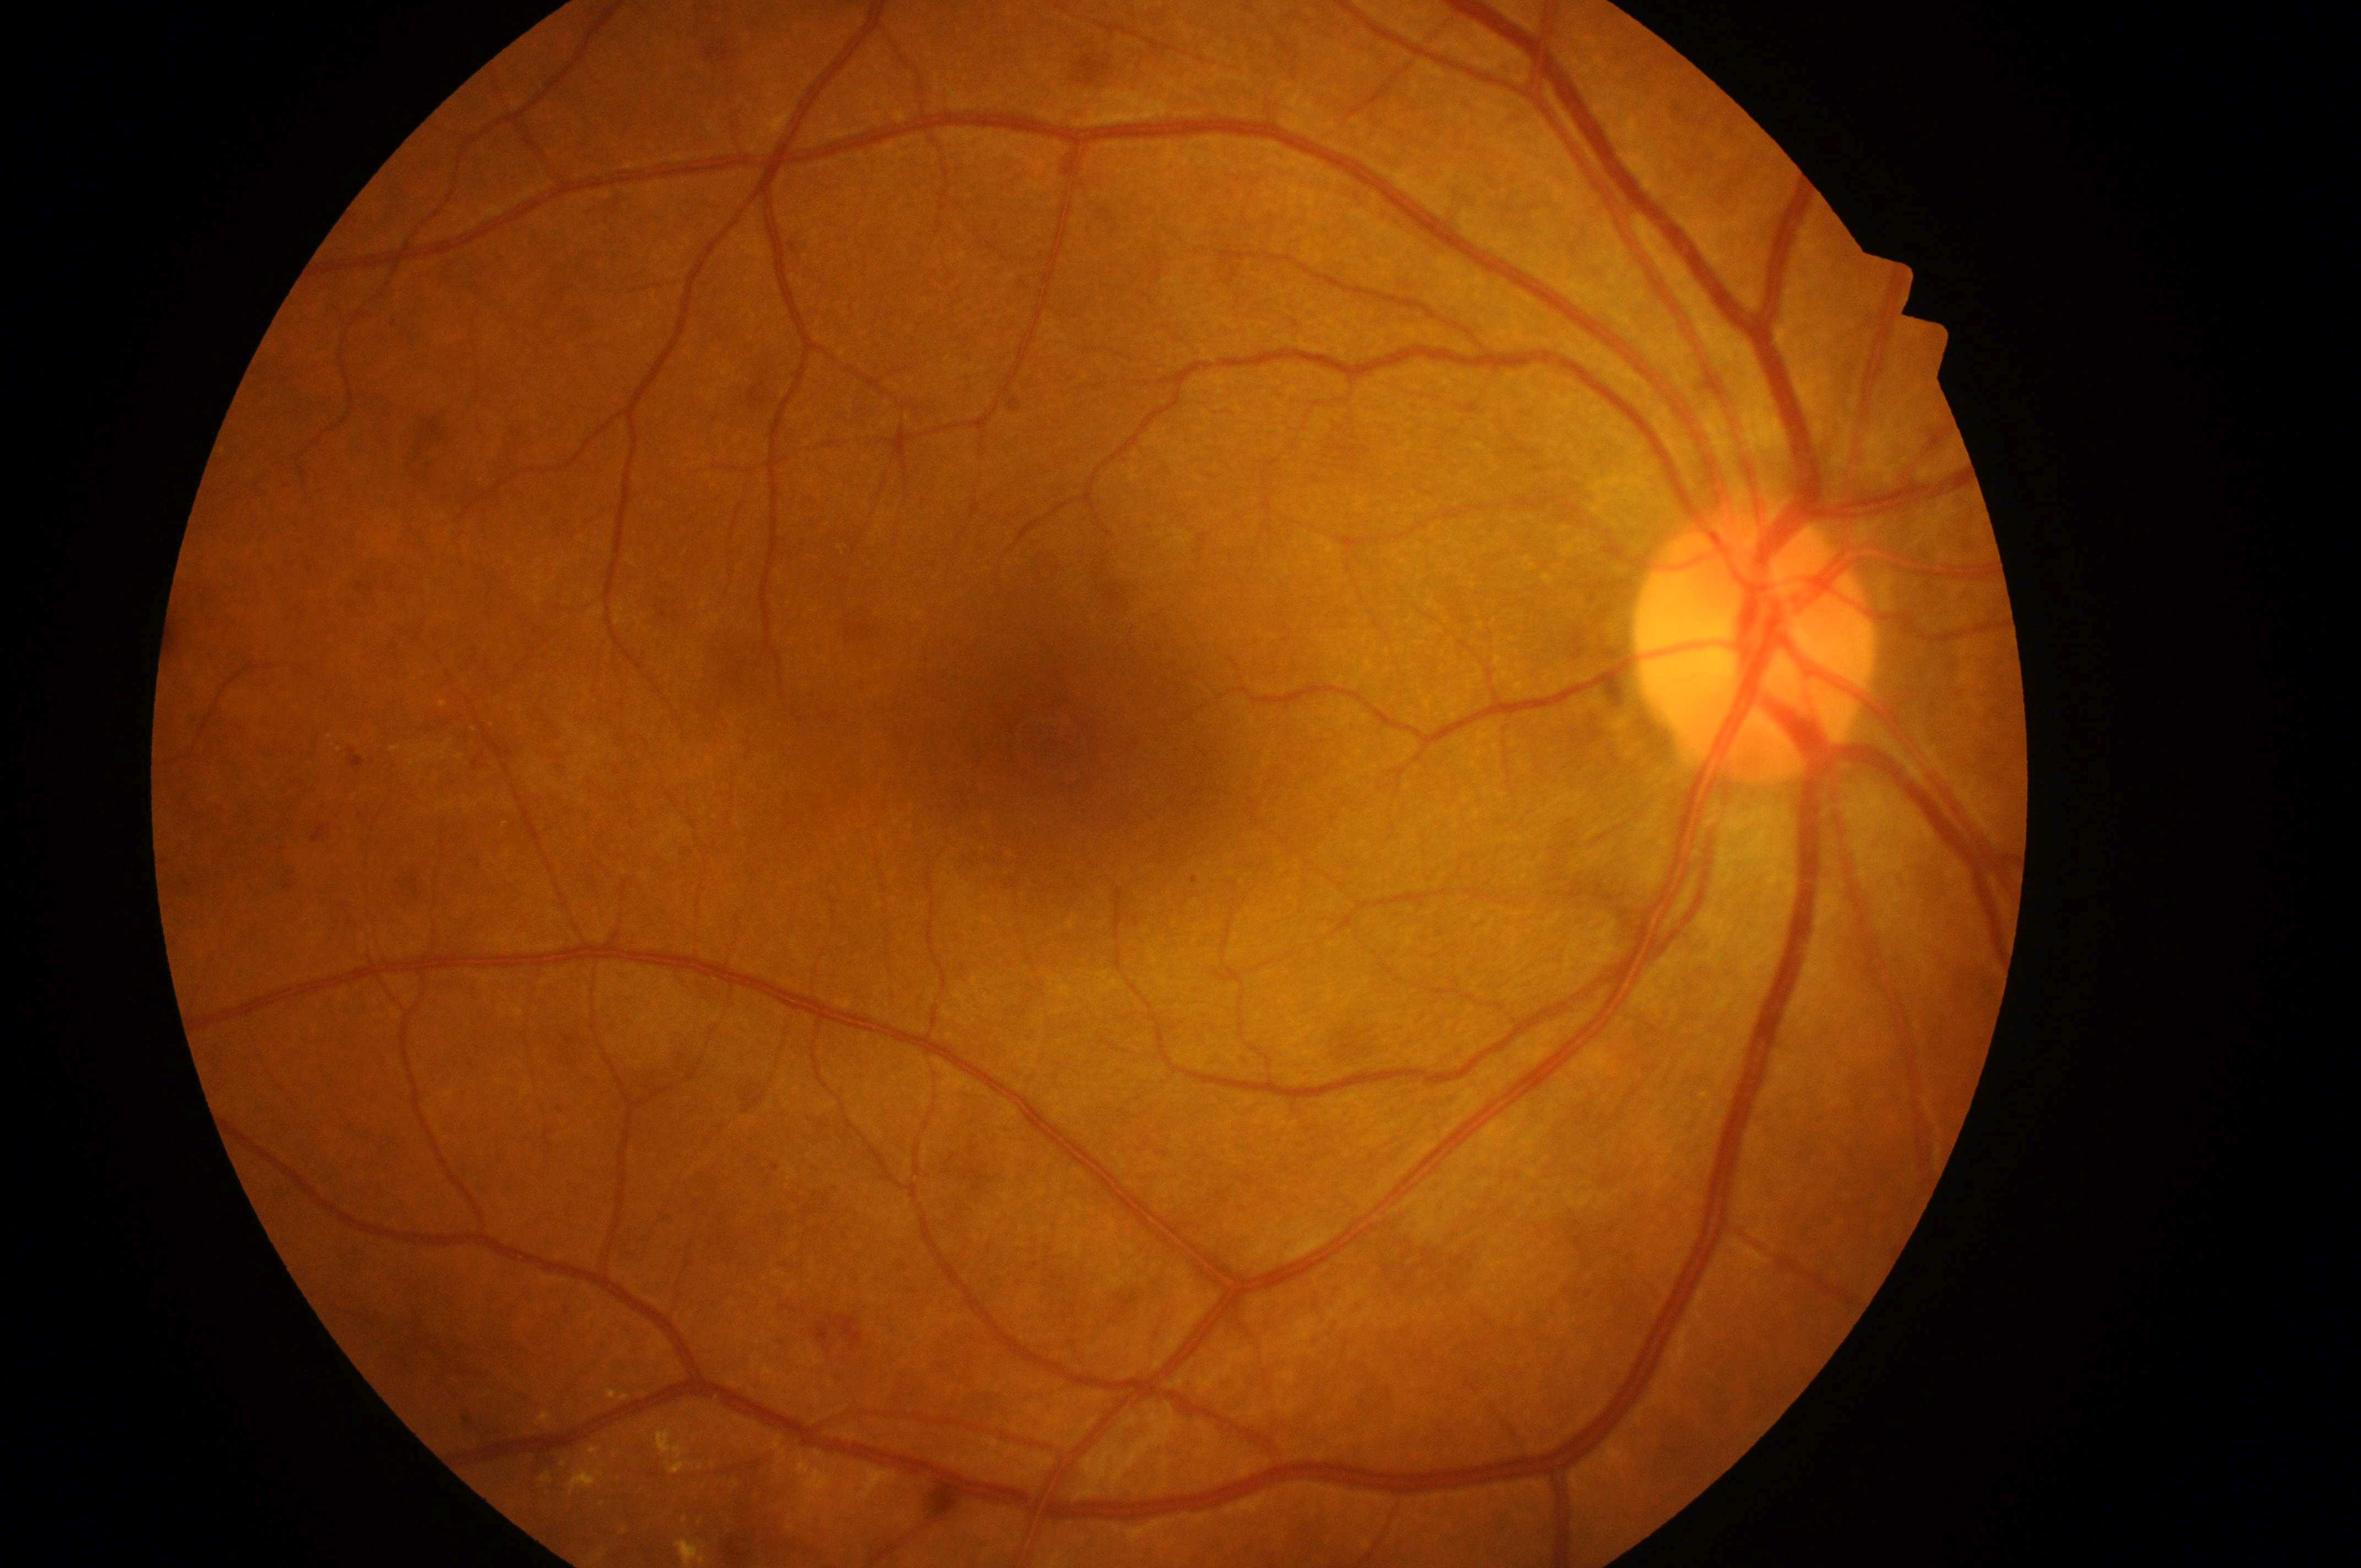
This is the right eye. Disc center located at (x: 1755, y: 645). Diabetic macular edema (DME): grade 1 (low risk). Fovea located at (x: 1068, y: 771). Diabetic retinopathy (DR): grade 2 (moderate NPDR).